NIDEK AFC-230; Davis DR grading.
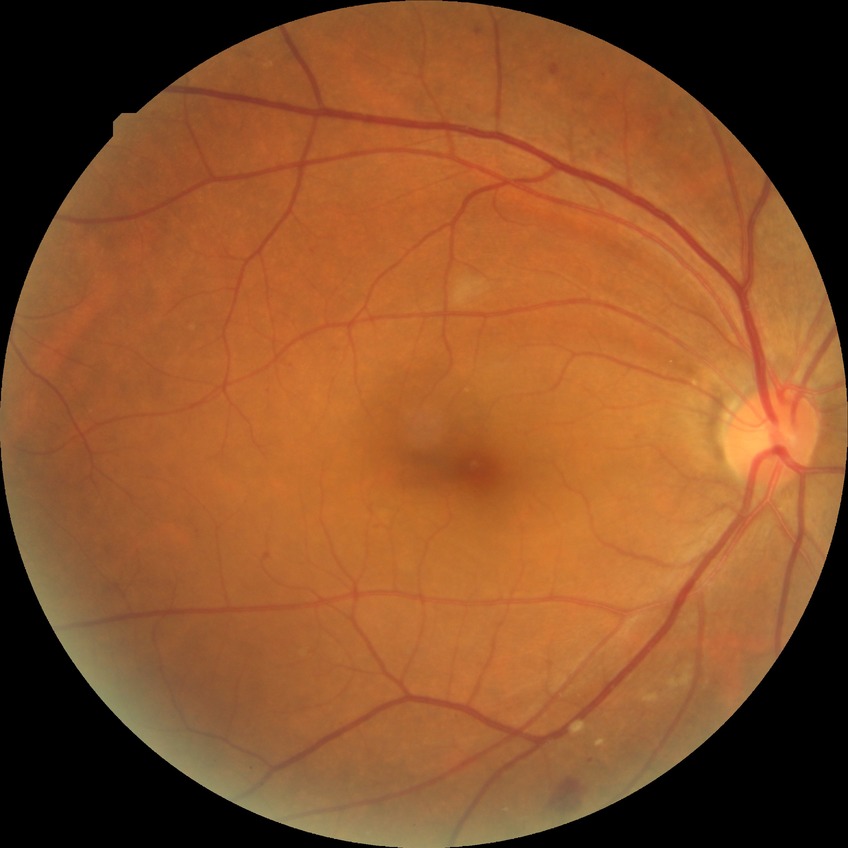 Diabetic retinopathy stage is pre-proliferative diabetic retinopathy.